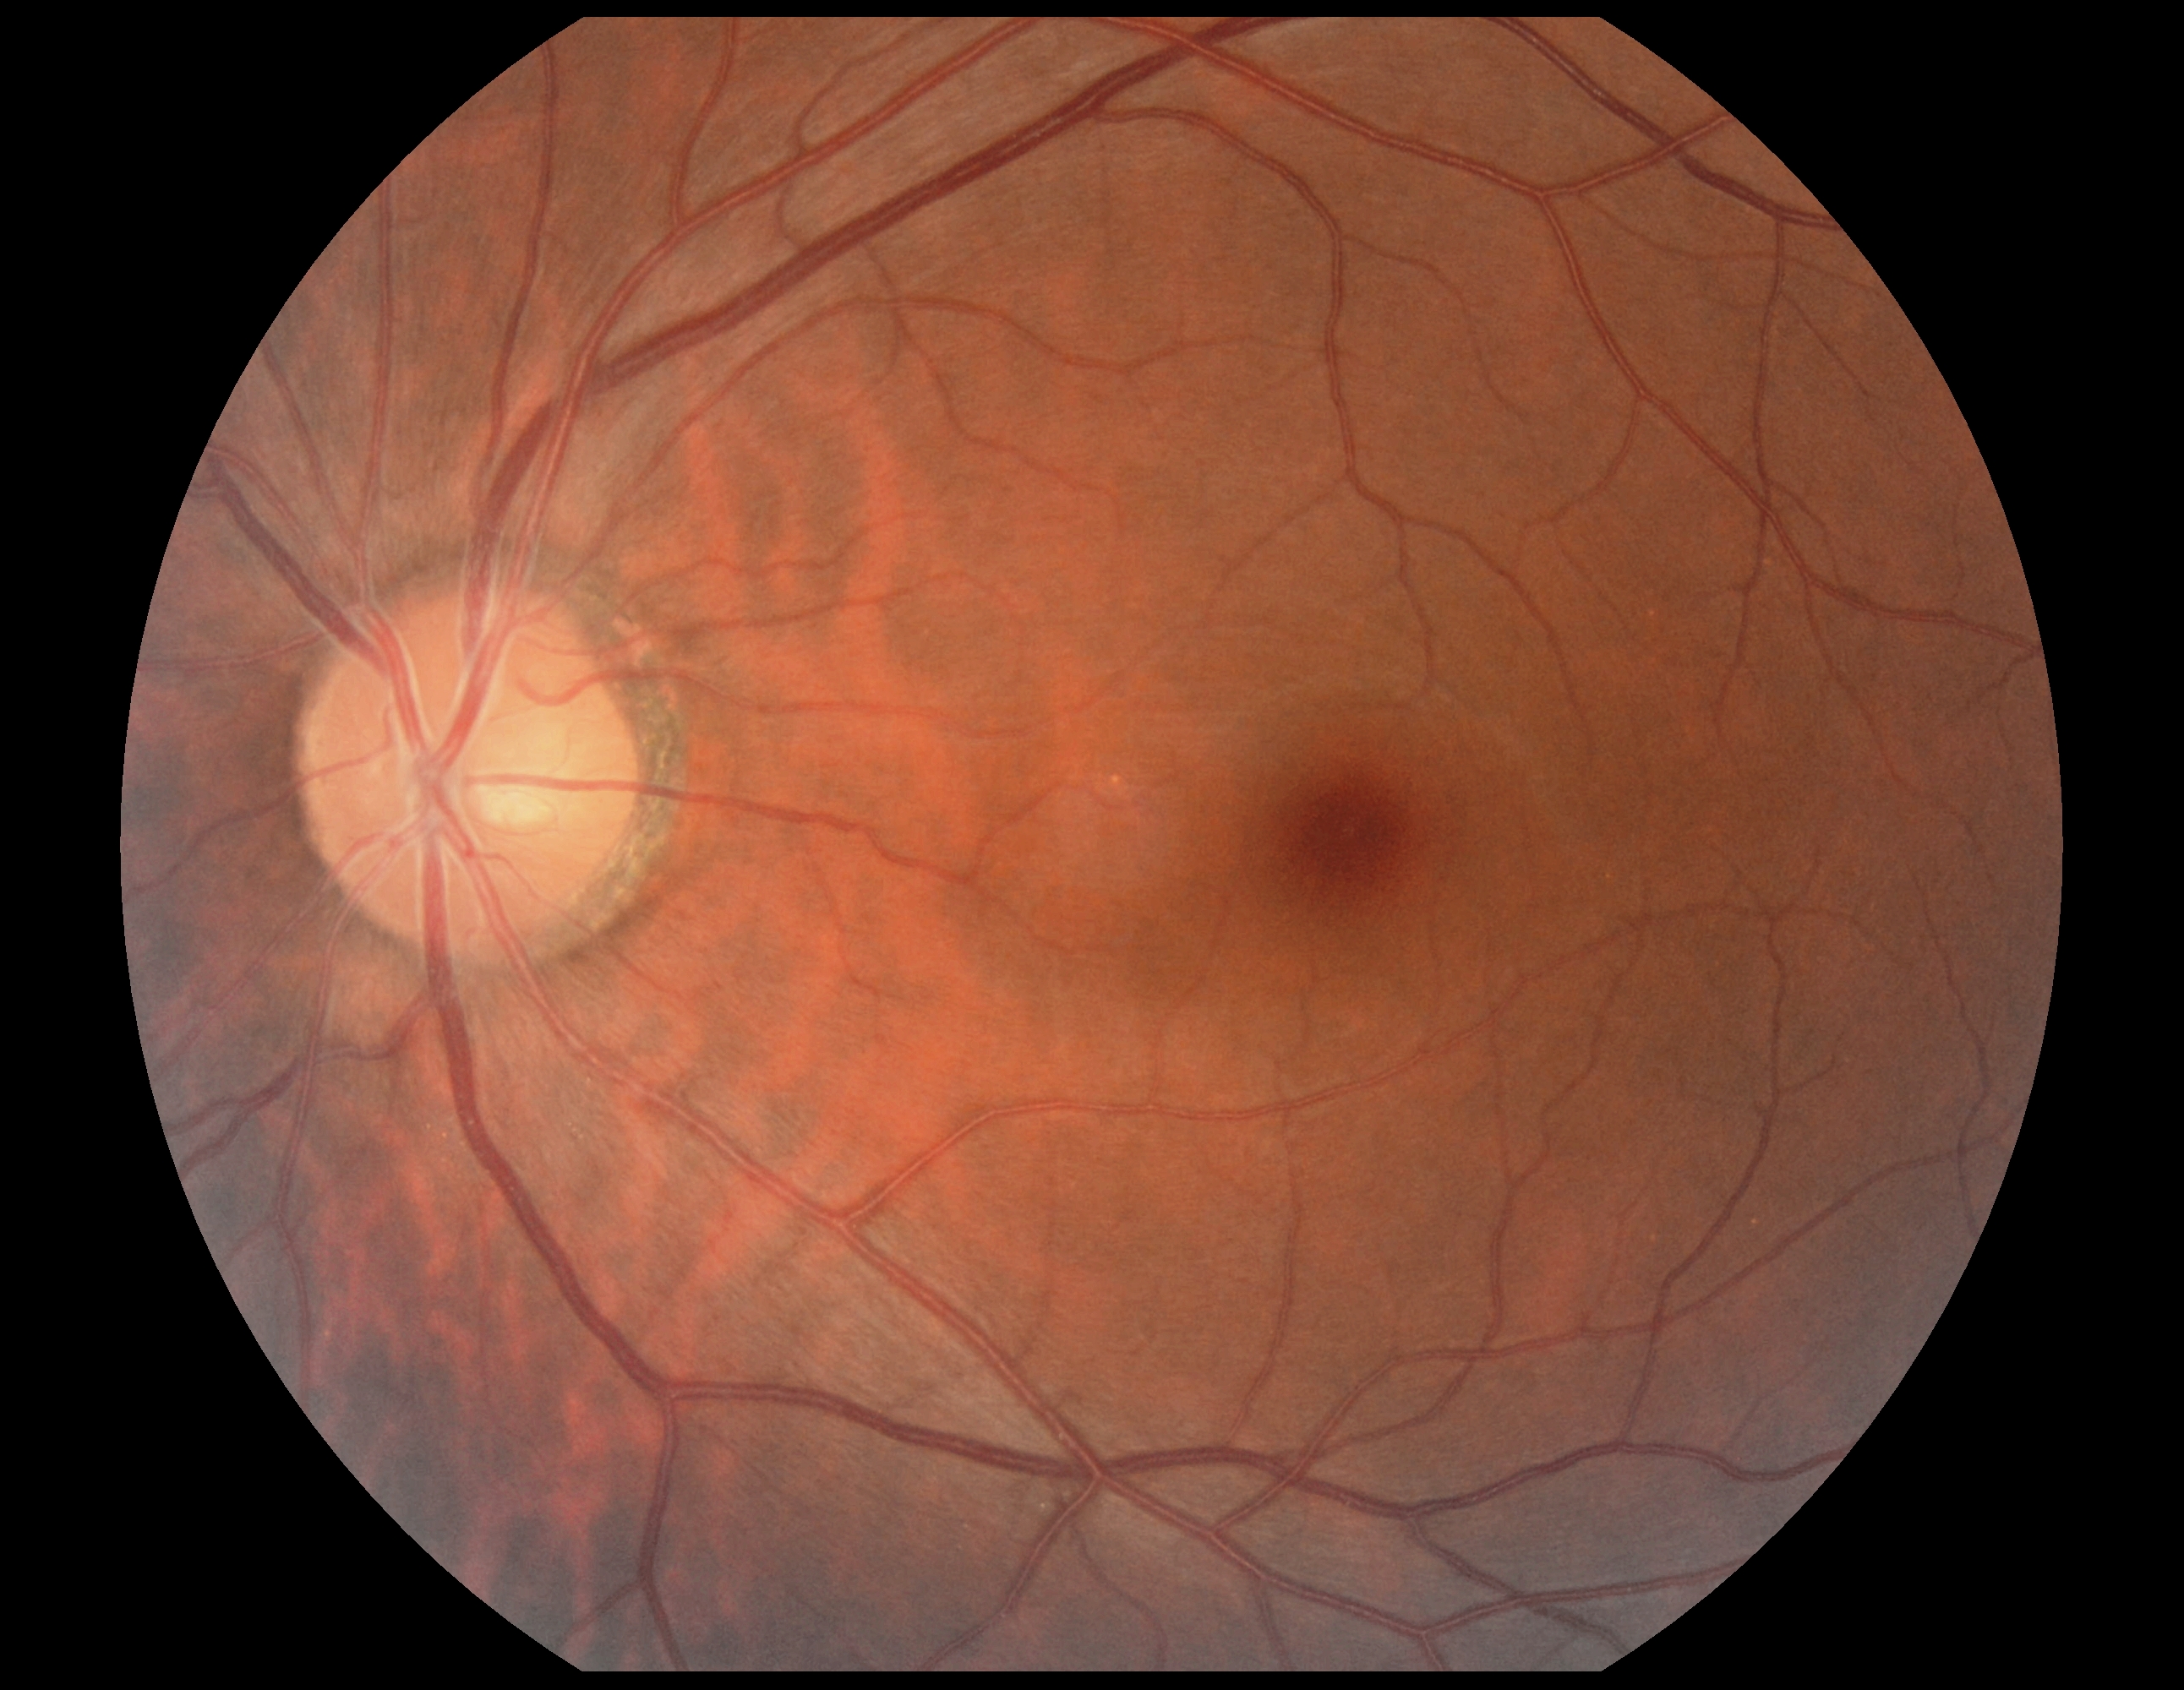
Diabetic retinopathy grade is 0/4.
No signs of diabetic retinopathy.